Graded on the modified Davis scale; NIDEK AFC-230 fundus camera — 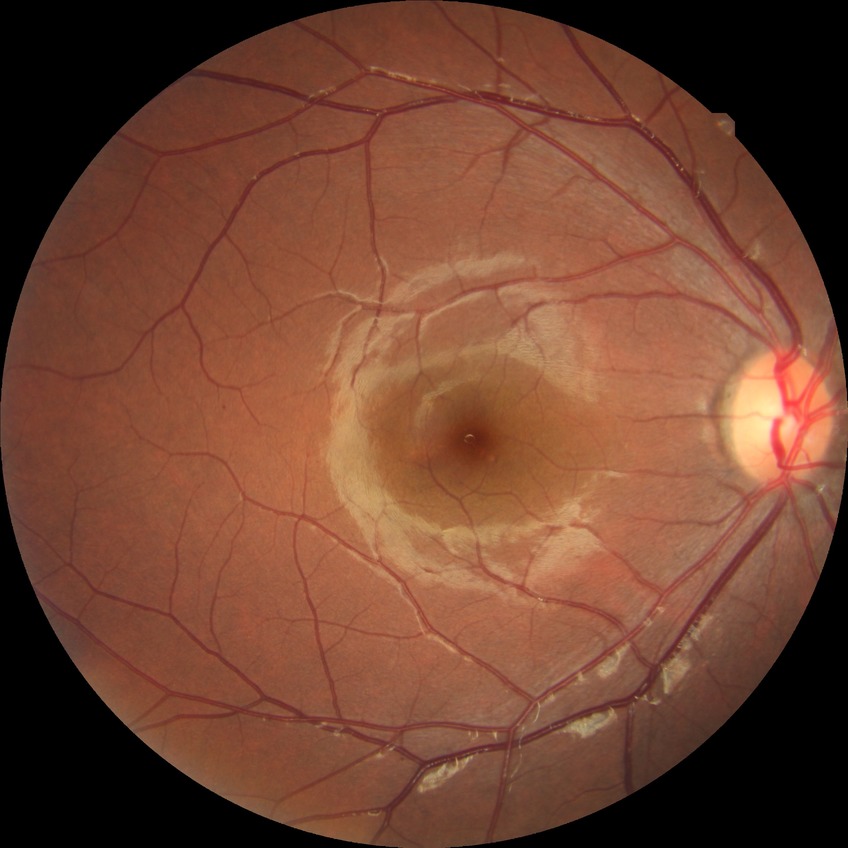

  davis_grade: SDR (simple diabetic retinopathy)